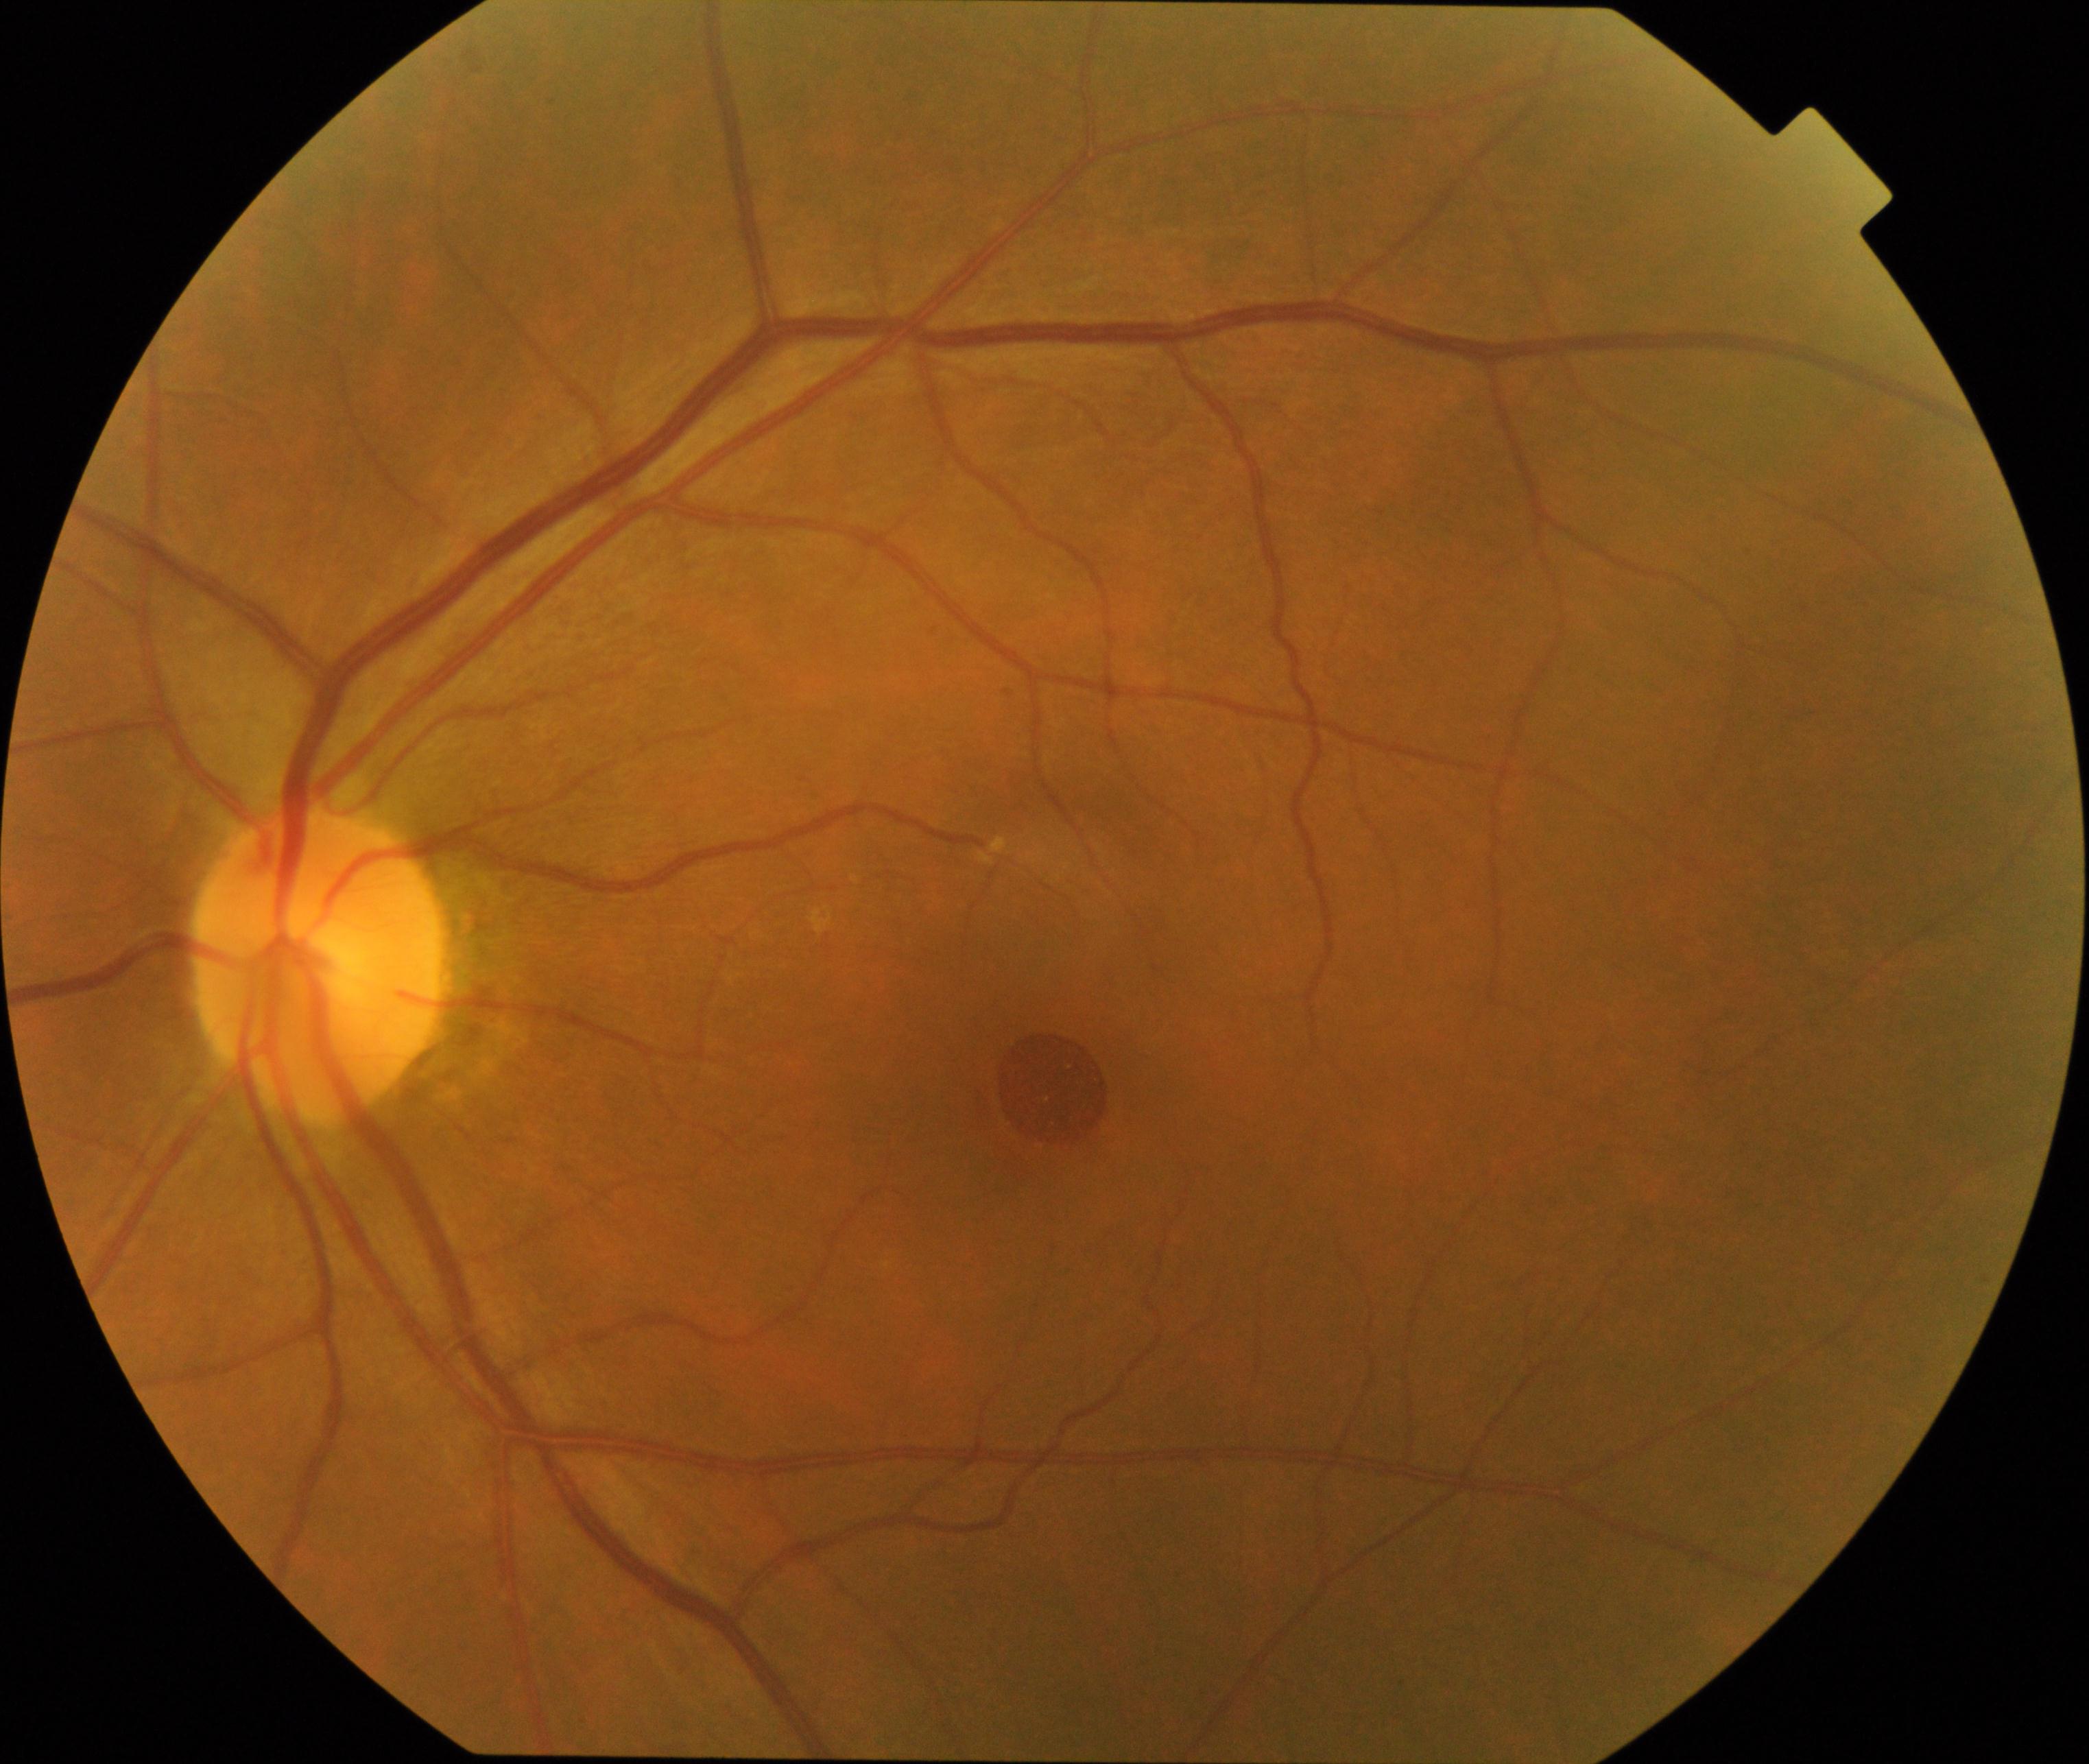
Consistent with MH (macular hole).